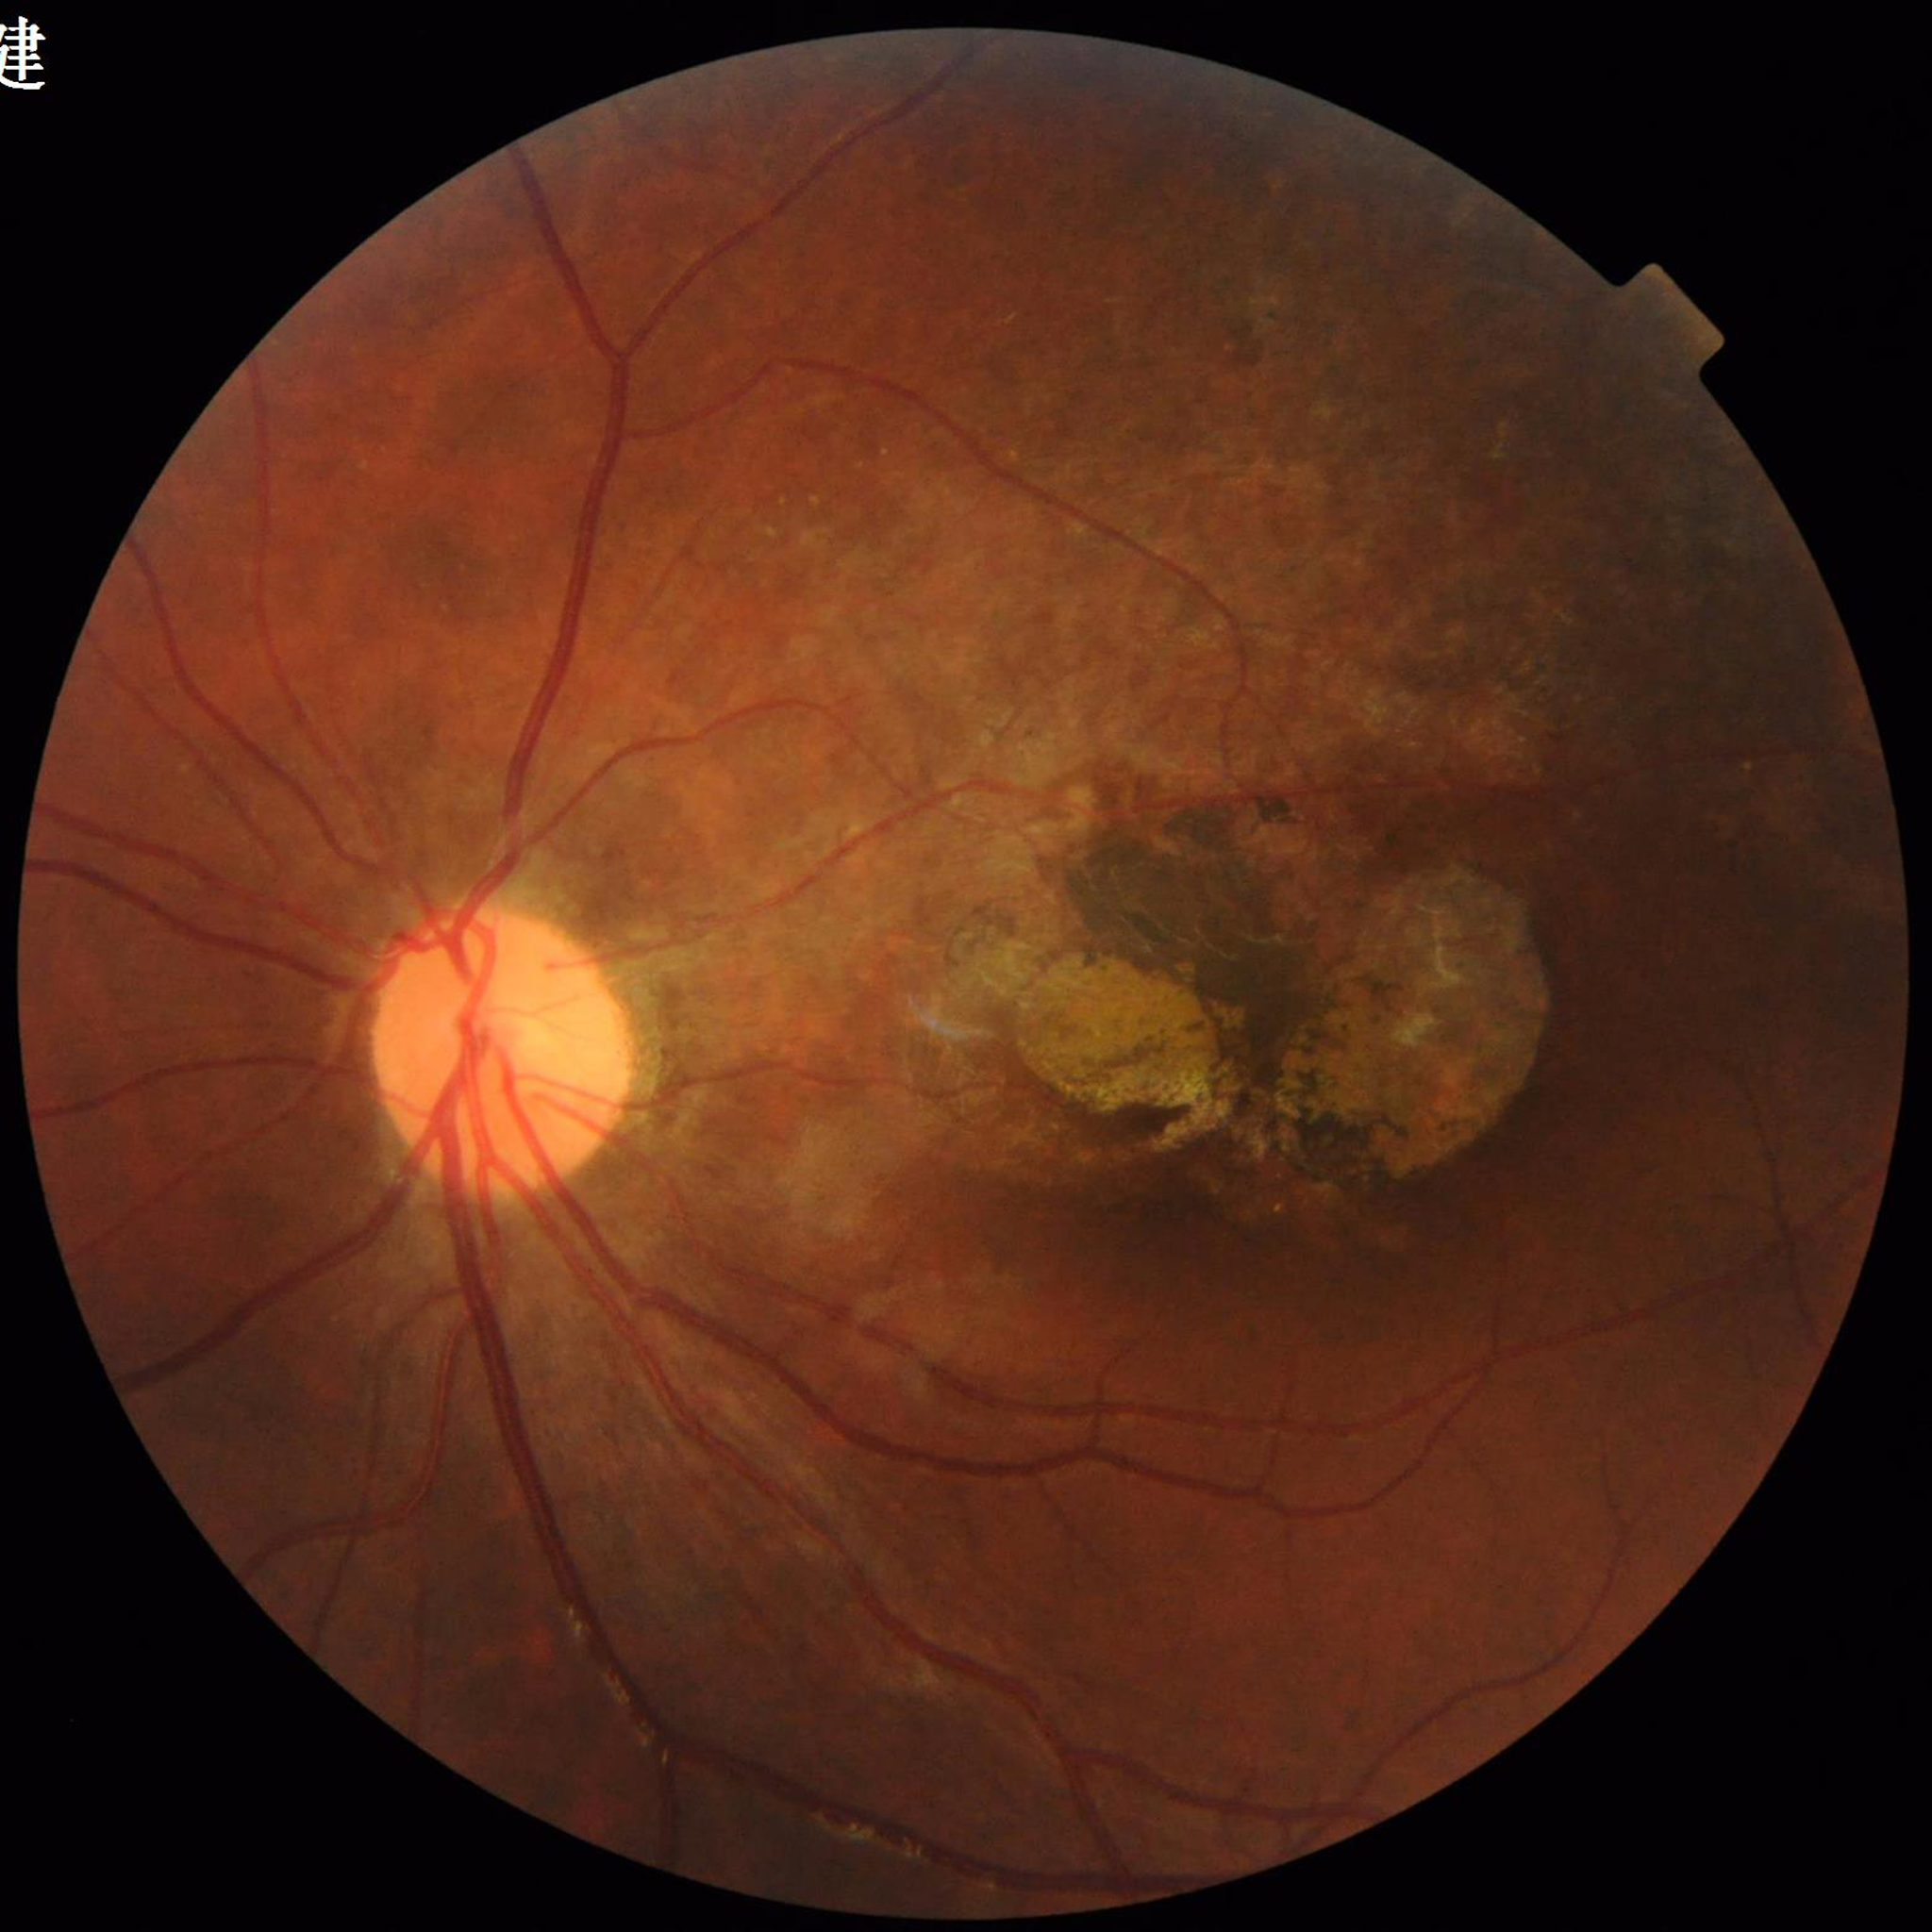
Image quality: no quality issues identified
Disease: AMD